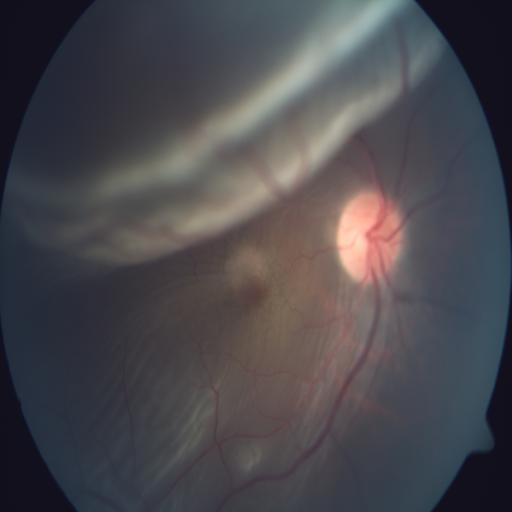
Diagnoses: retinal detachment.